Davis DR grading, 45 degree fundus photograph
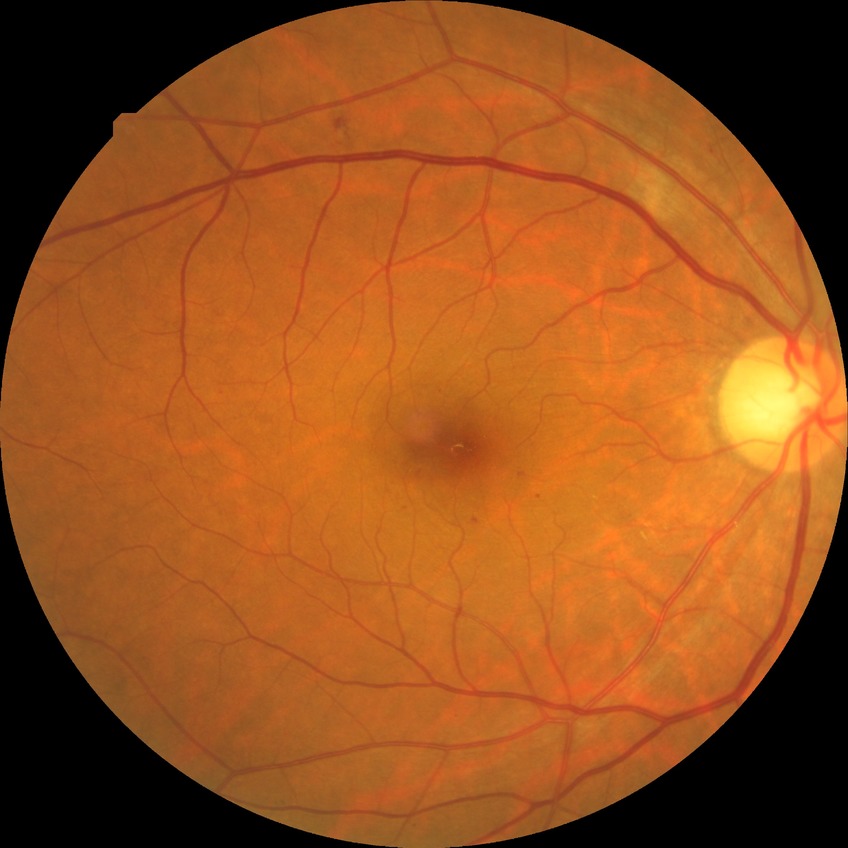 diabetic retinopathy (DR): simple diabetic retinopathy (SDR).